848x848px, NIDEK AFC-230, posterior pole photograph.
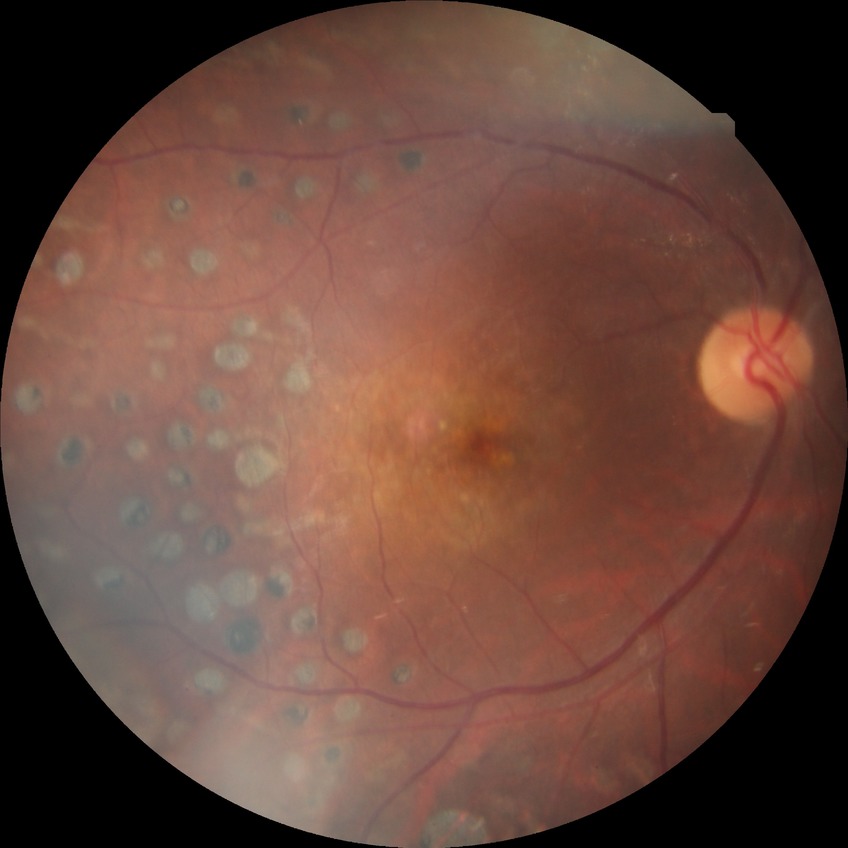 Diabetic retinopathy (DR): NDR (no diabetic retinopathy).